Captured on a Topcon TRC-50DX fundus camera, CFP — 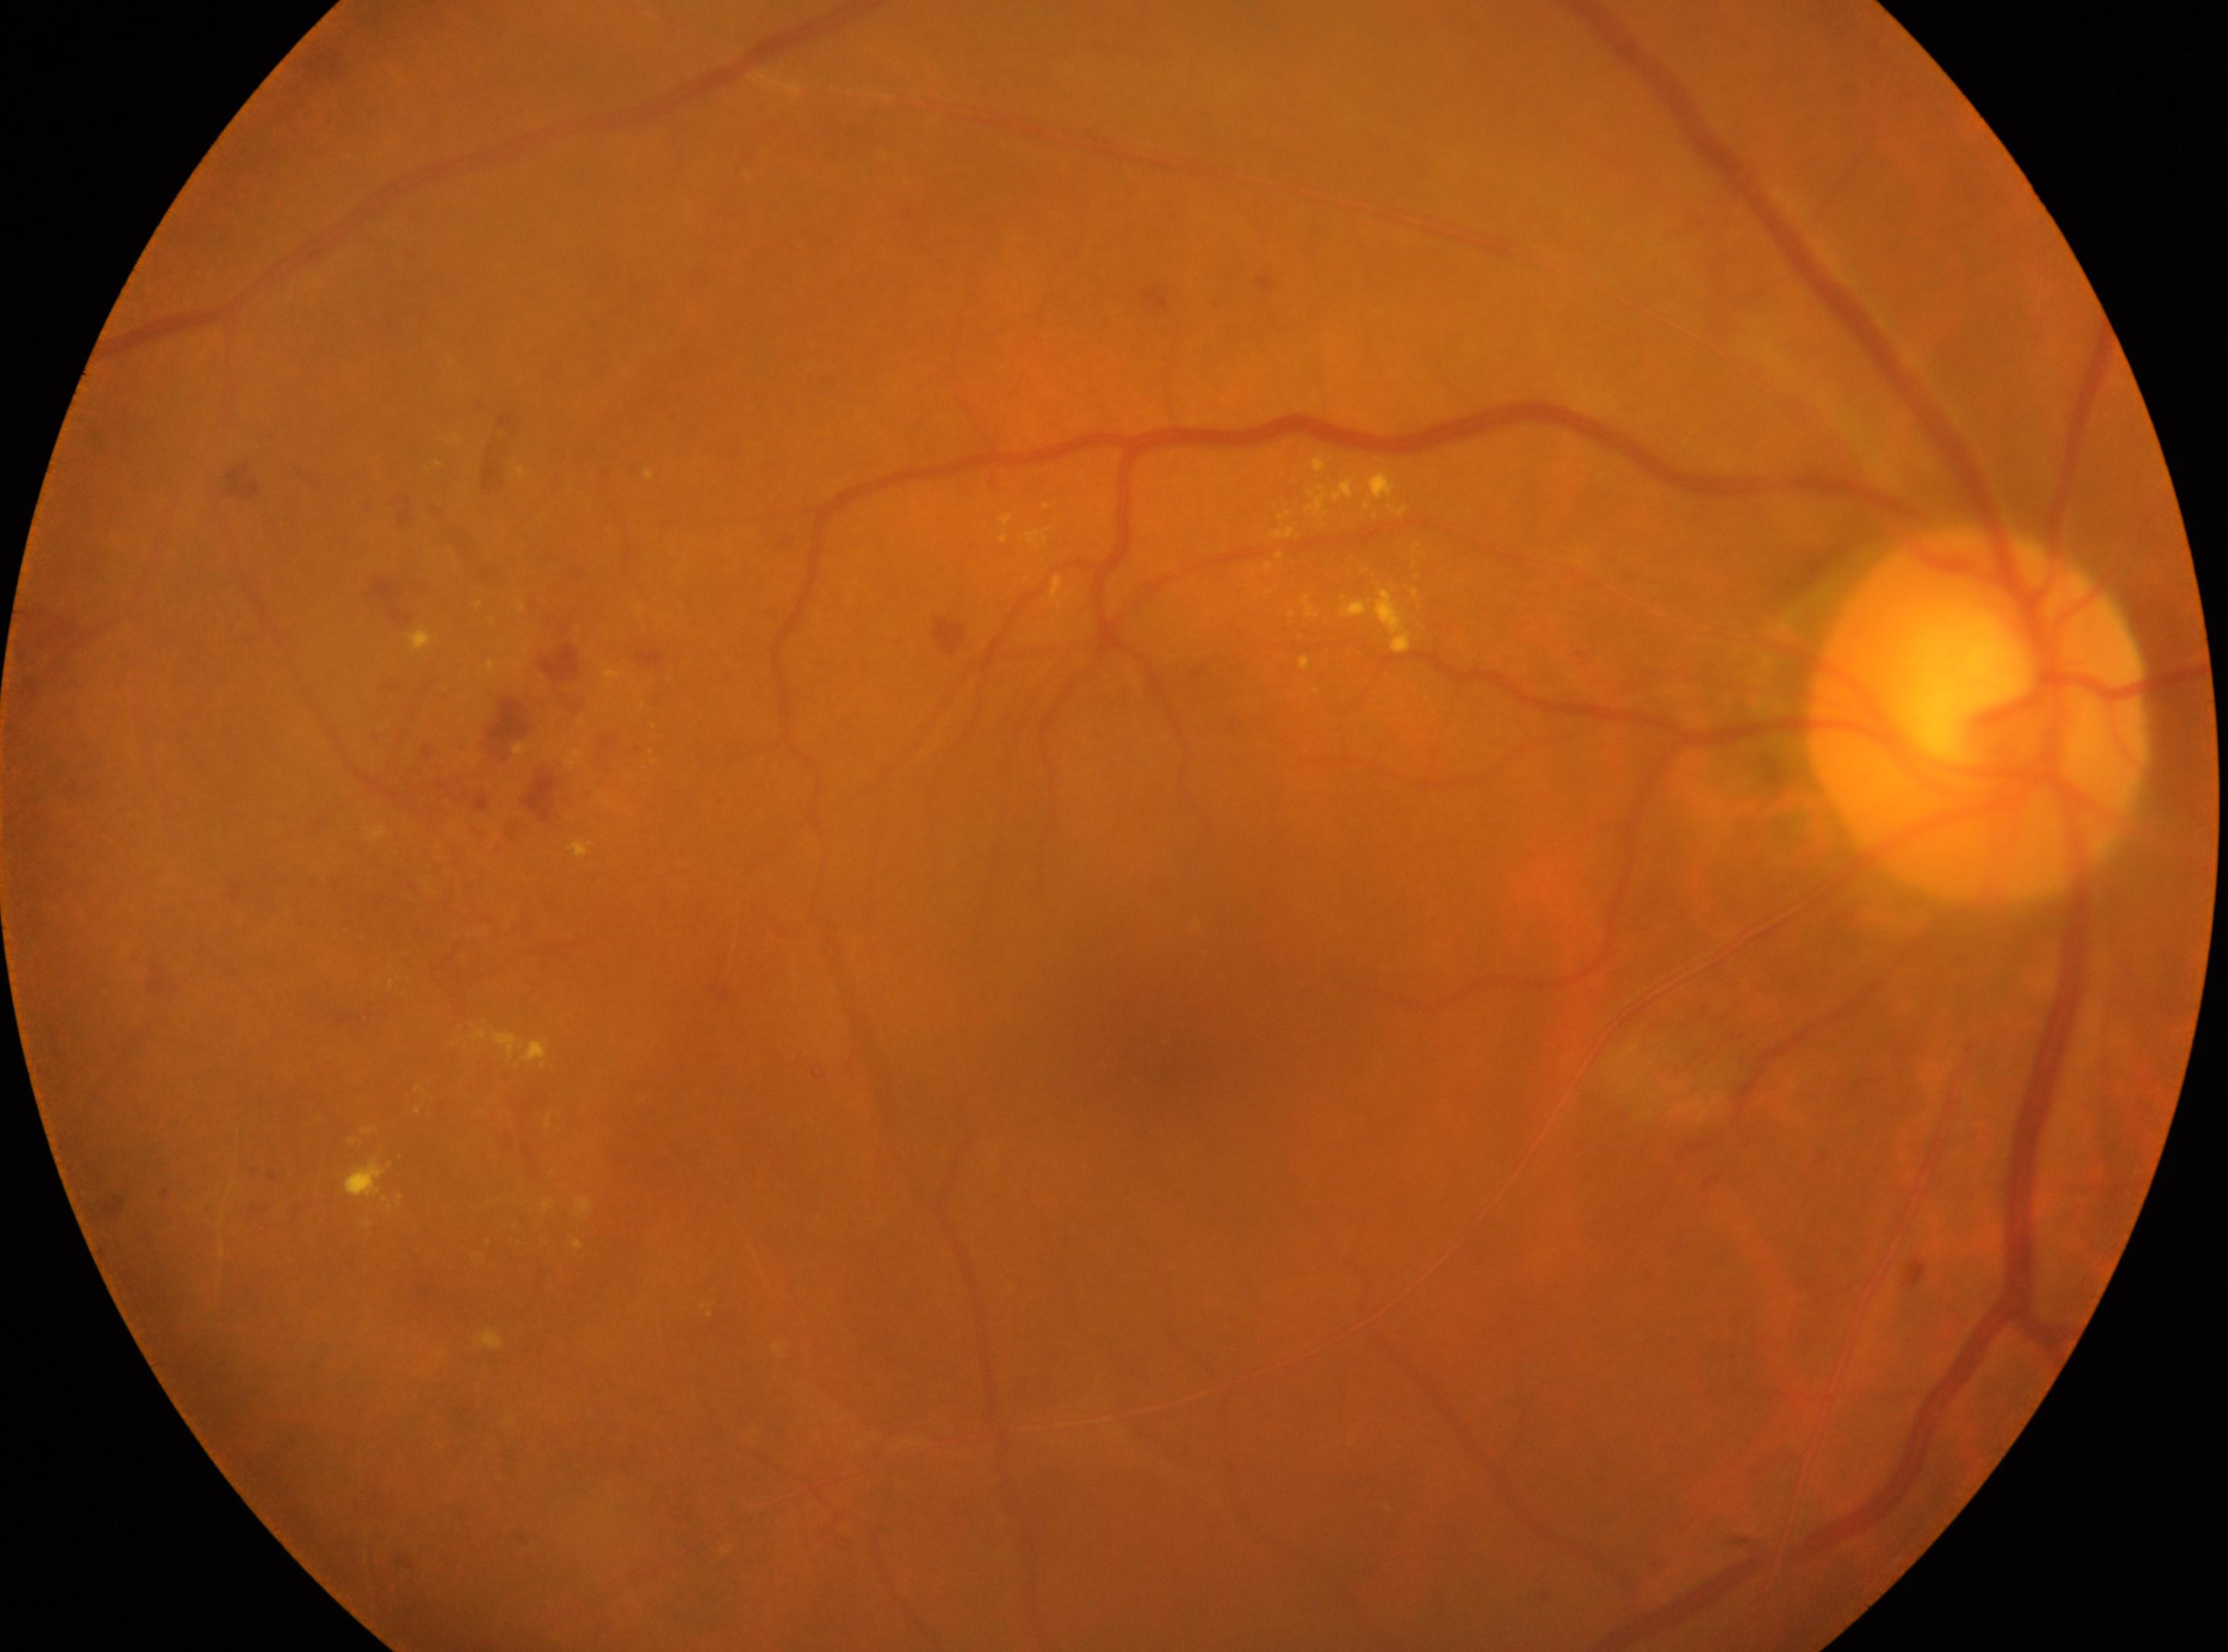
optic disk: (x=1977, y=714); macular center: (x=1165, y=1033); diabetic retinopathy: grade 2 (moderate NPDR); oculus dexter.